Diabetic retinopathy graded by the modified Davis classification.
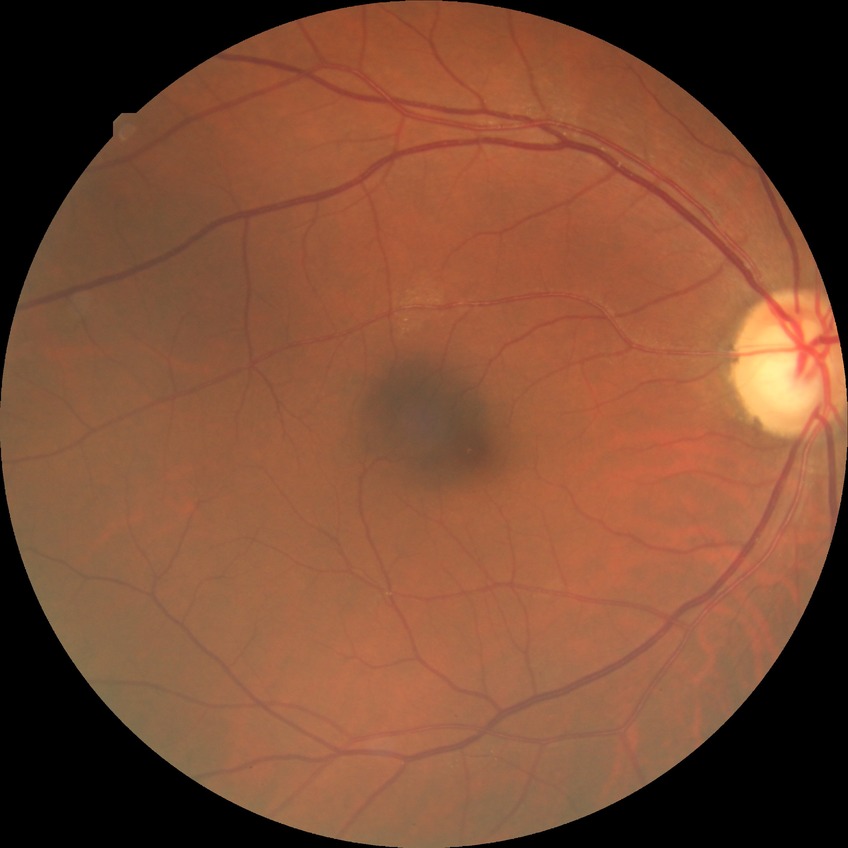
diabetic retinopathy (DR)=NDR (no diabetic retinopathy).